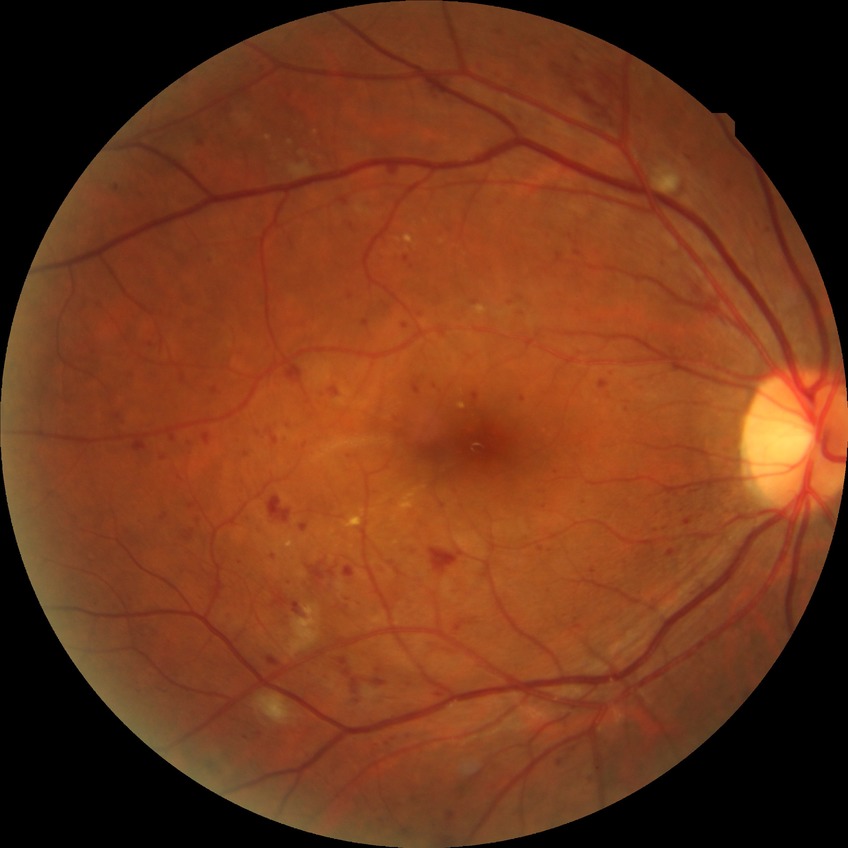 DR grade: PPDR.